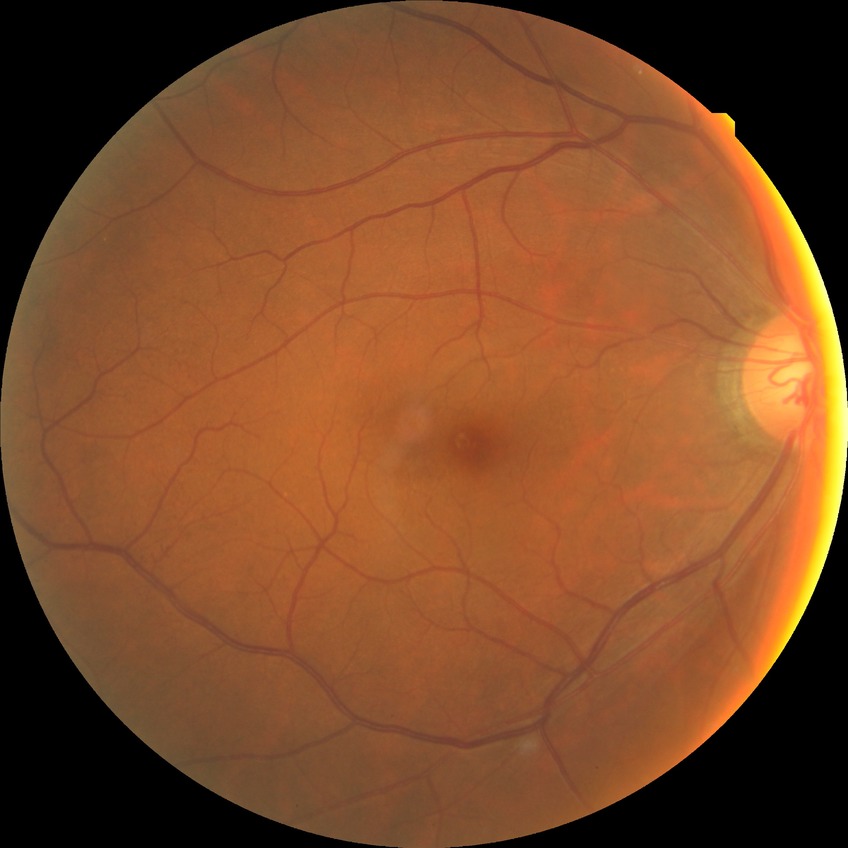
Diabetic retinopathy severity: no diabetic retinopathy.